Nonmydriatic fundus photograph · 45 degree fundus photograph · camera: NIDEK AFC-230 · DR severity per modified Davis staging · fundus photo · 848x848:
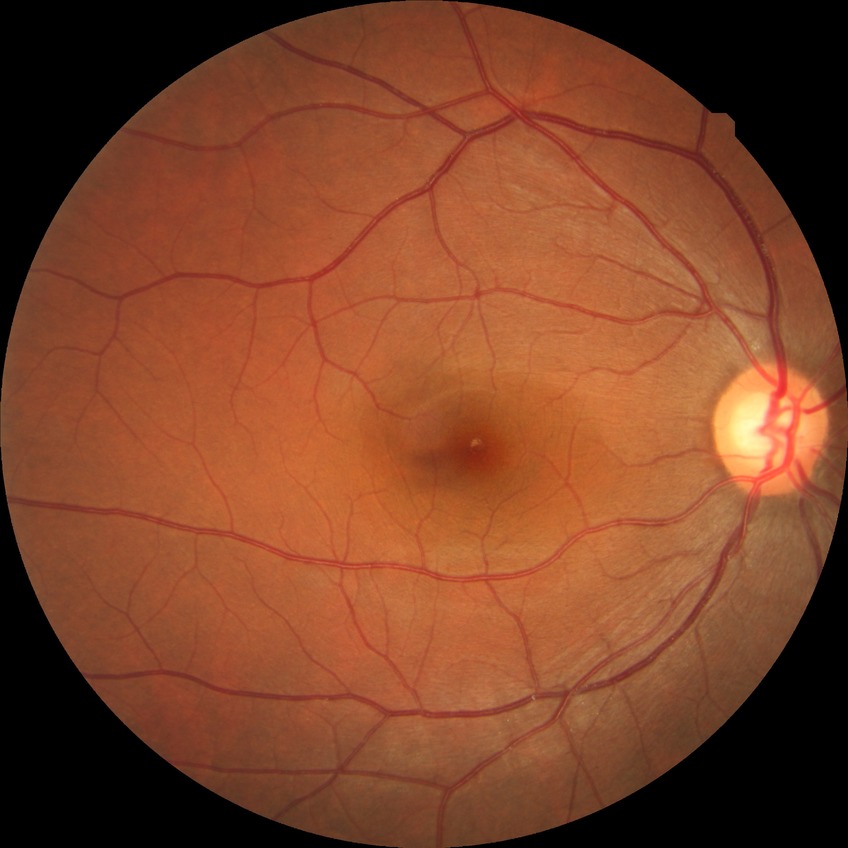 modified Davis grade@NDR.